NIDEK AFC-230 fundus camera, modified Davis classification: 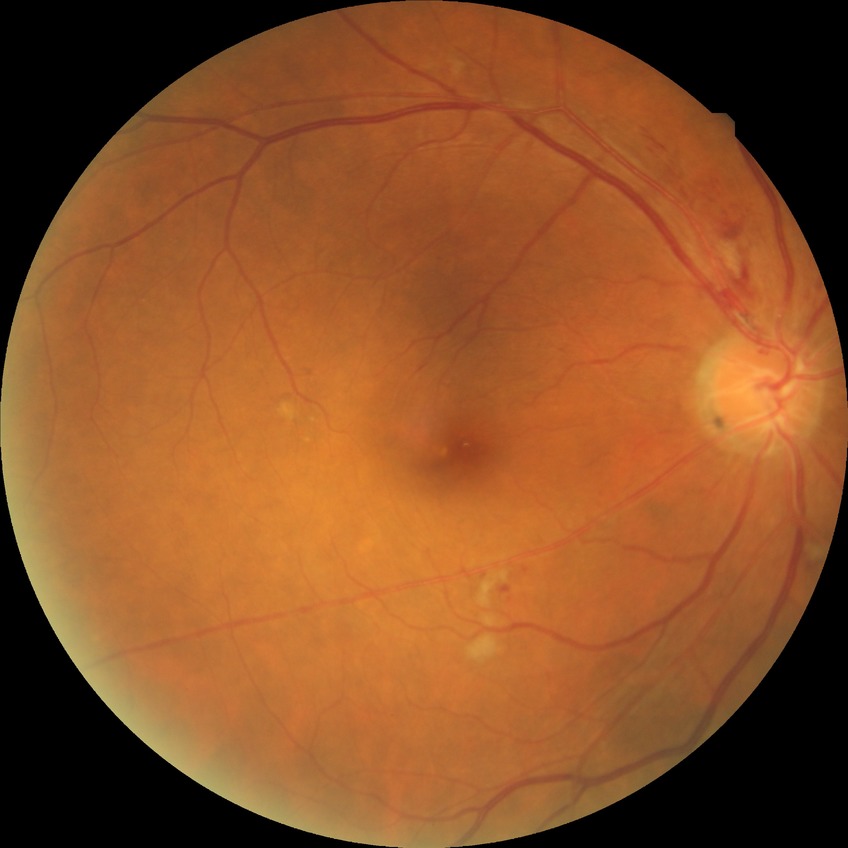

davis_grade: pre-proliferative diabetic retinopathy (PPDR)